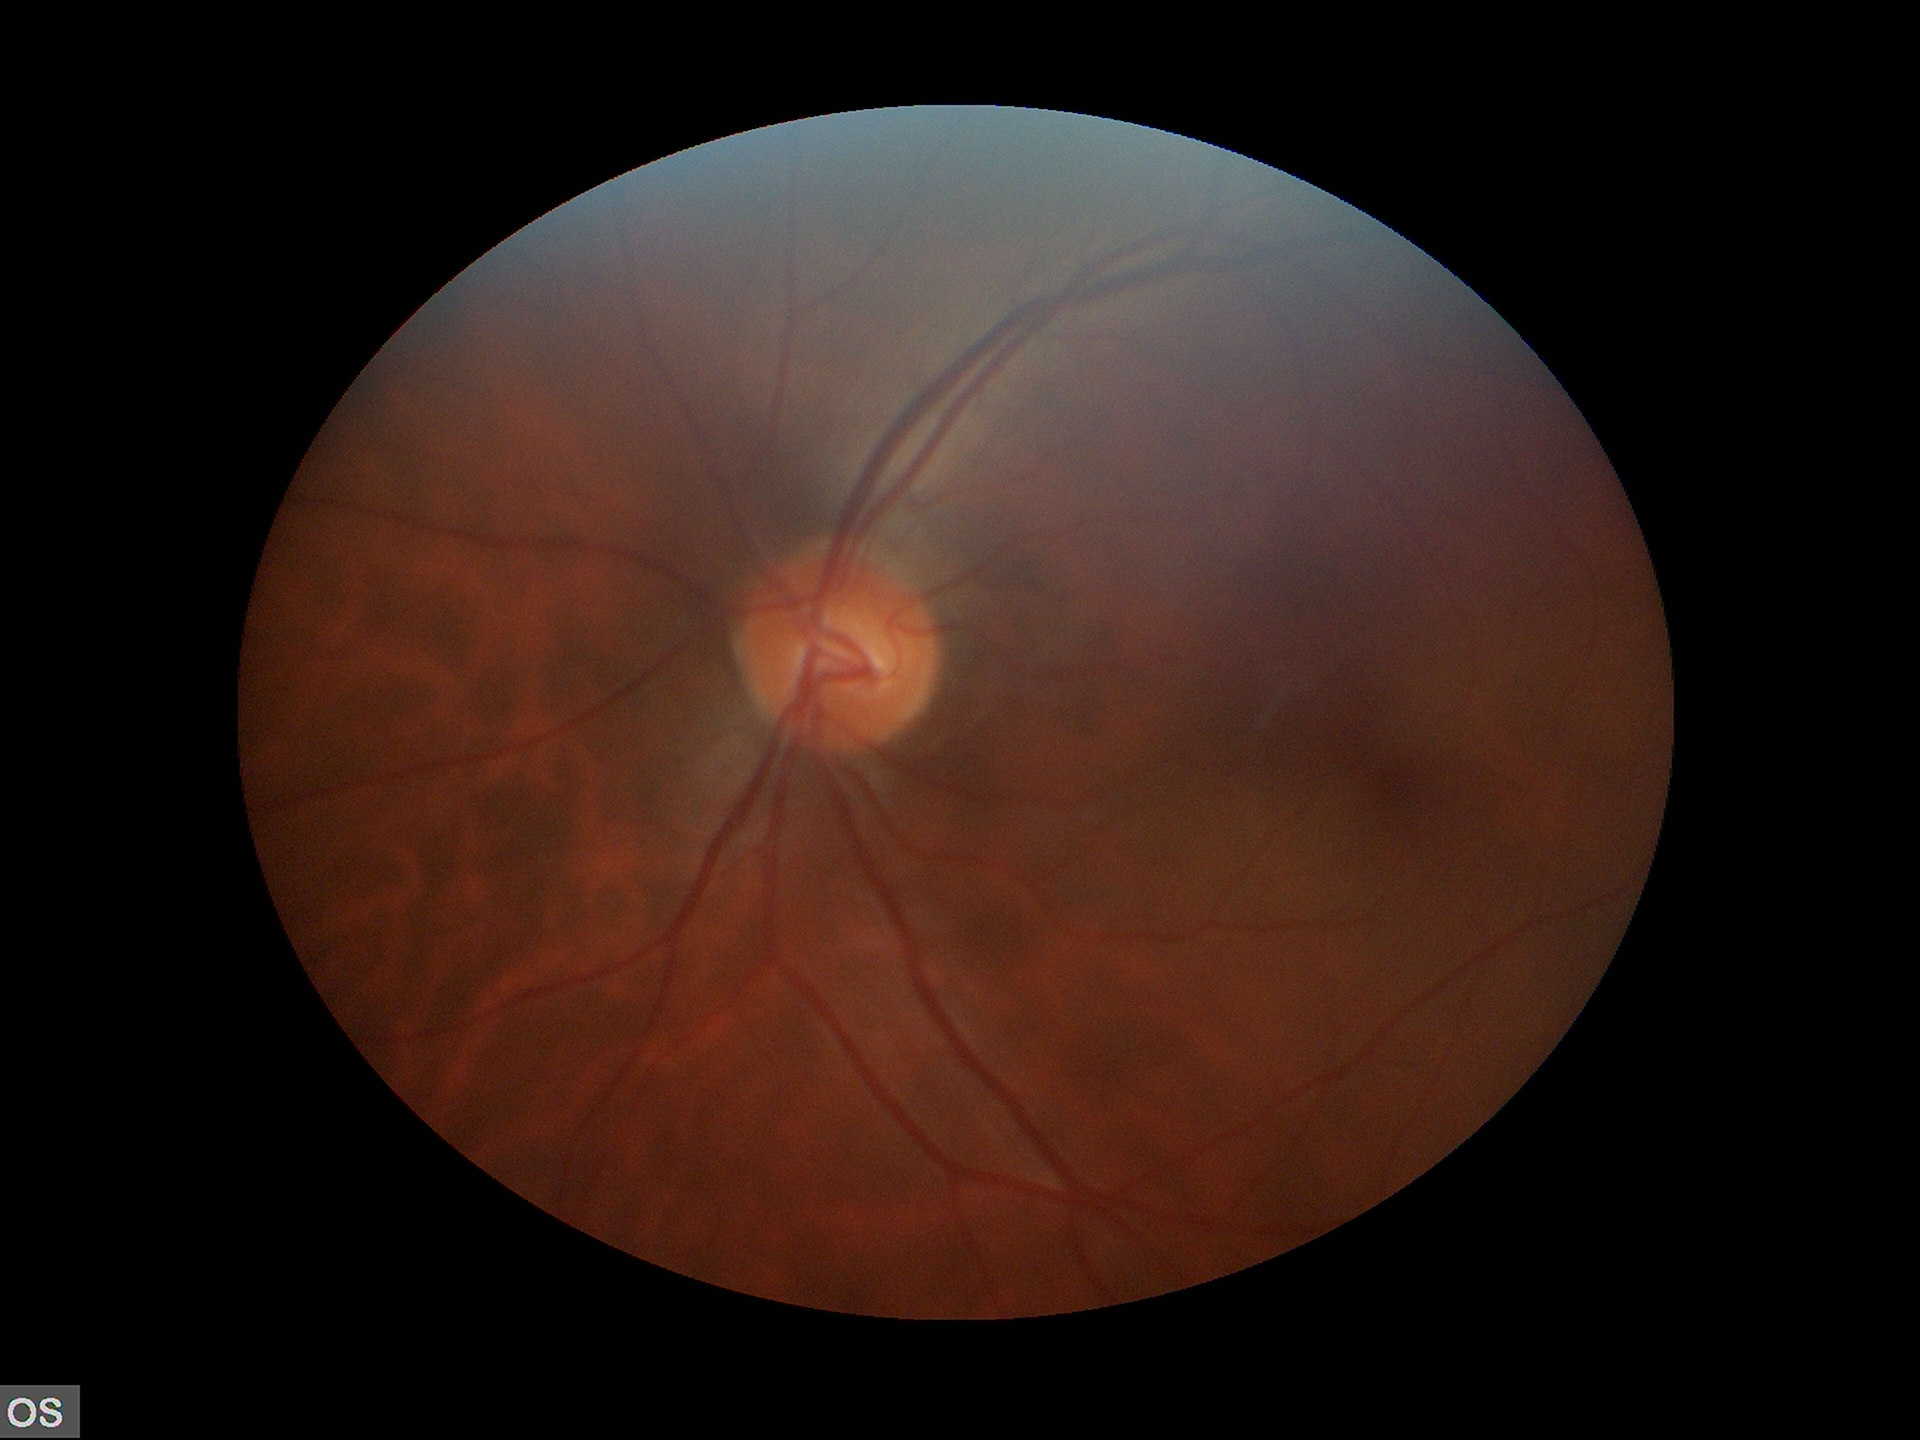 Area CDR is 0.23.
Vertical C/D ratio is 0.45.
No glaucomatous findings.